RetCam wide-field infant fundus image. 640x480px. Clarity RetCam 3, 130° FOV: 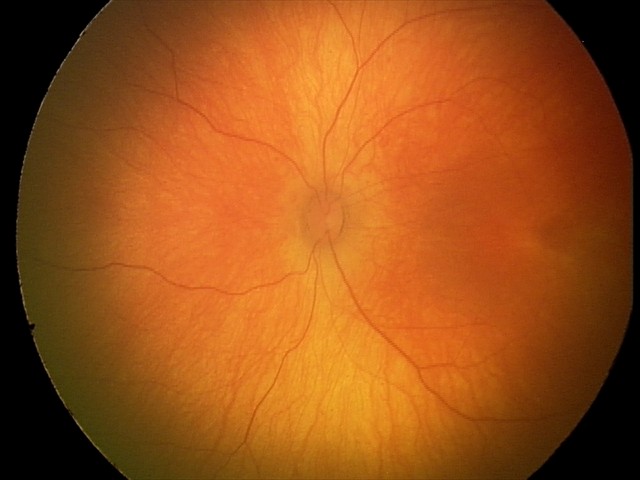 Physiological retinal appearance for postconceptual age.